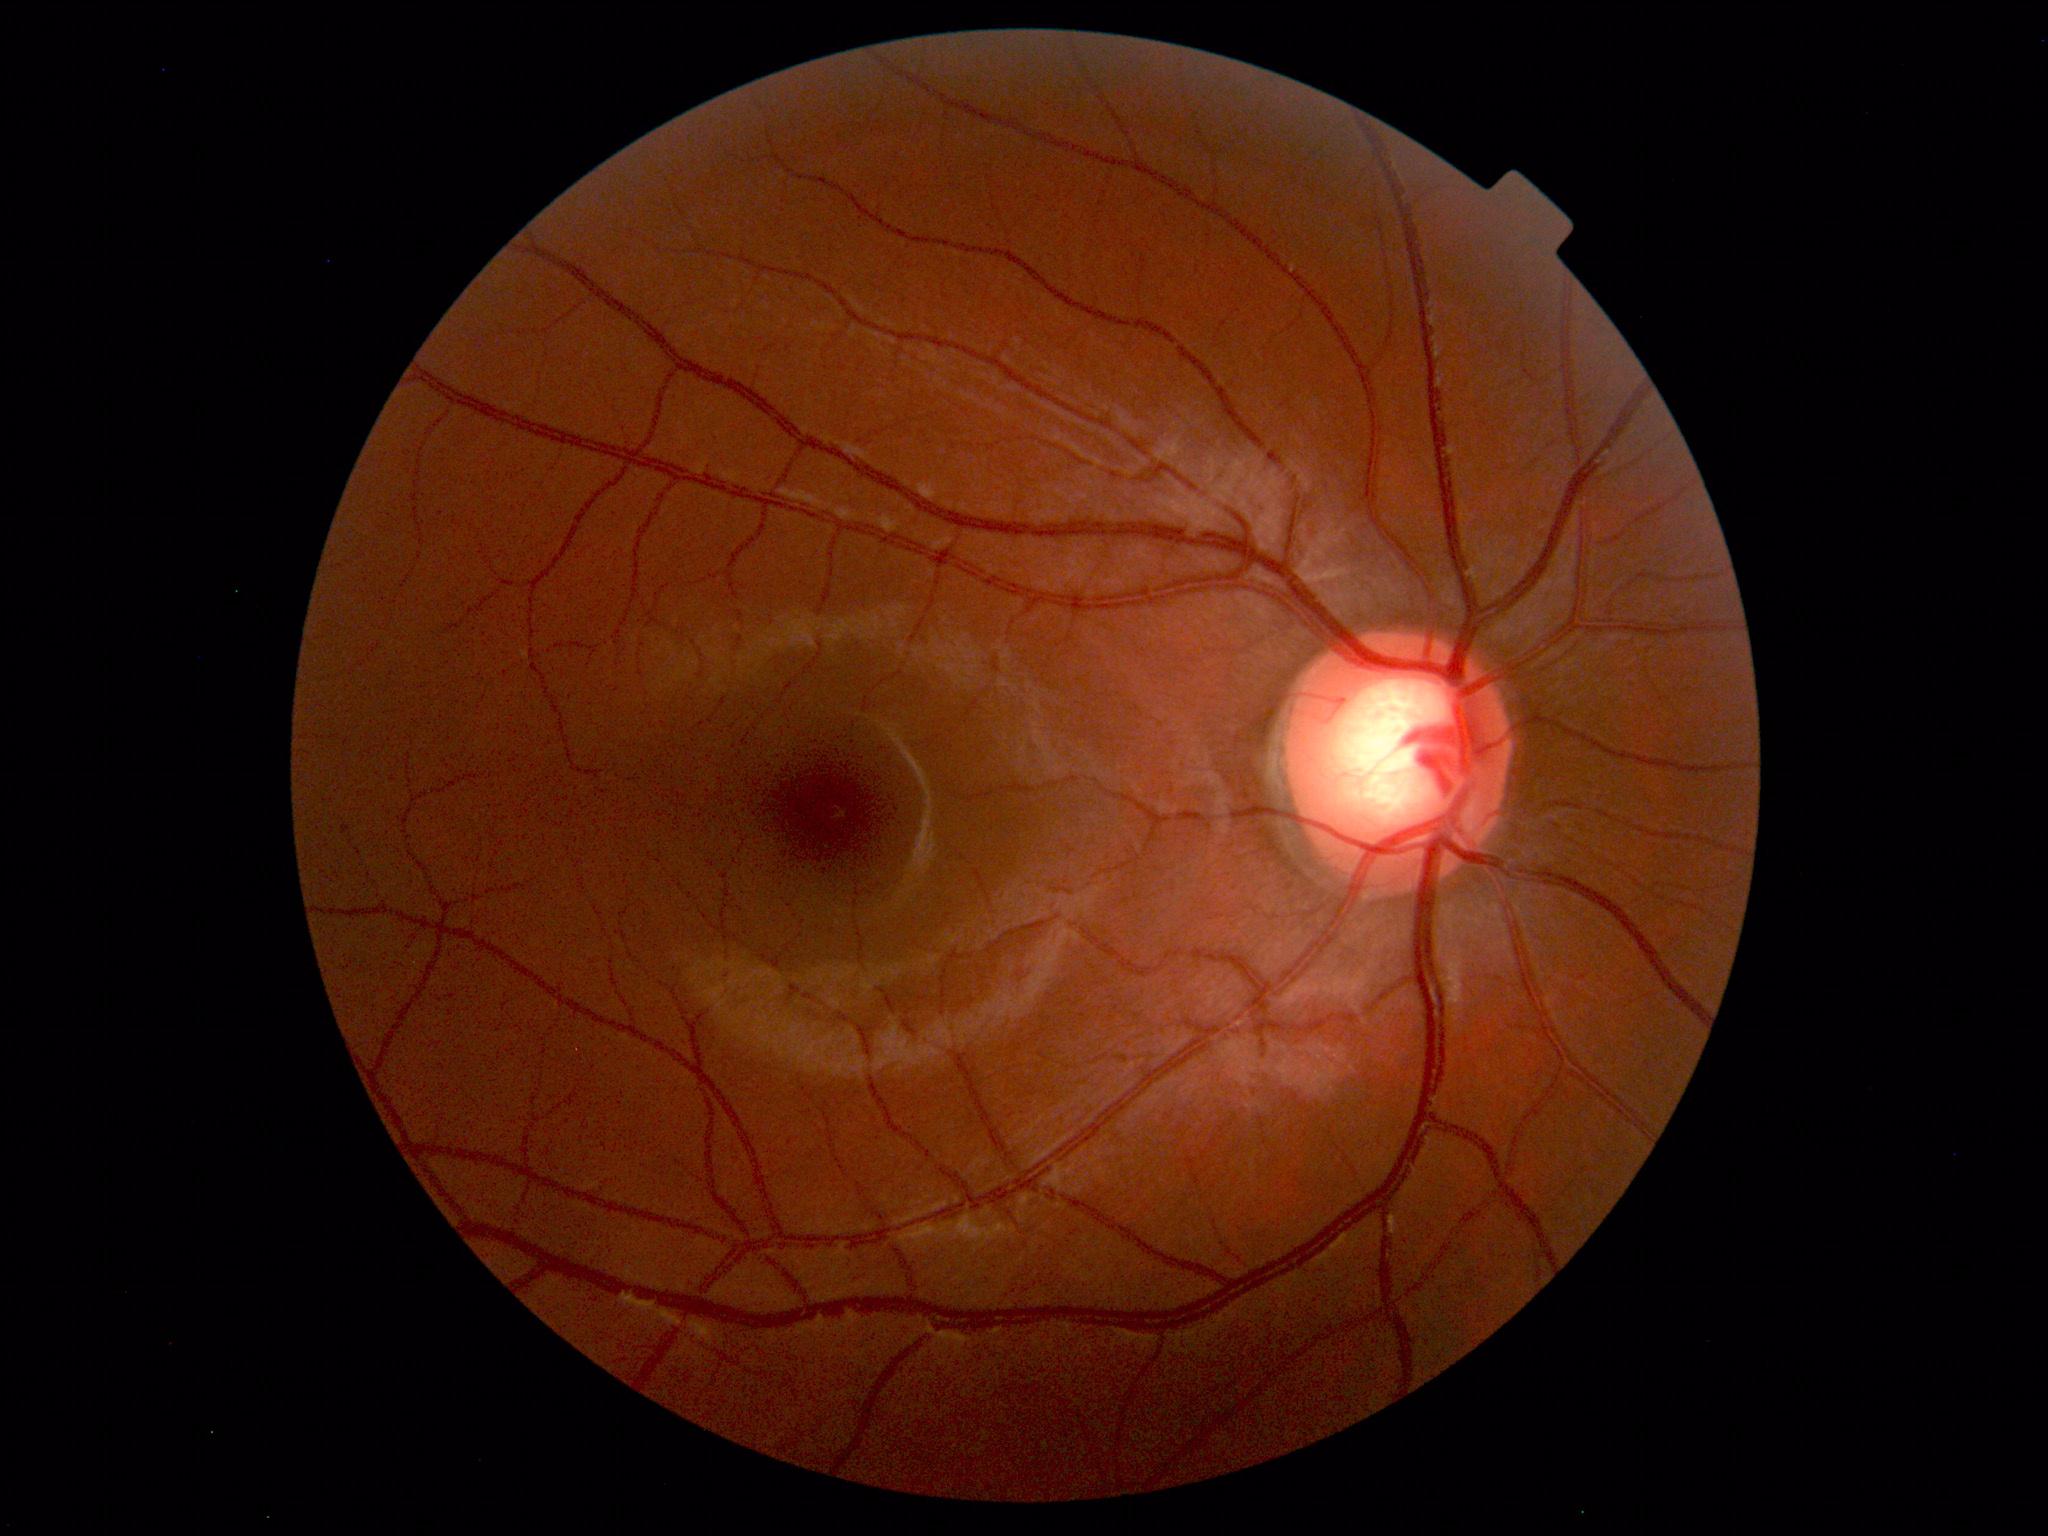
Diagnosis: normal.